Color fundus image · 2352 x 1568 pixels.
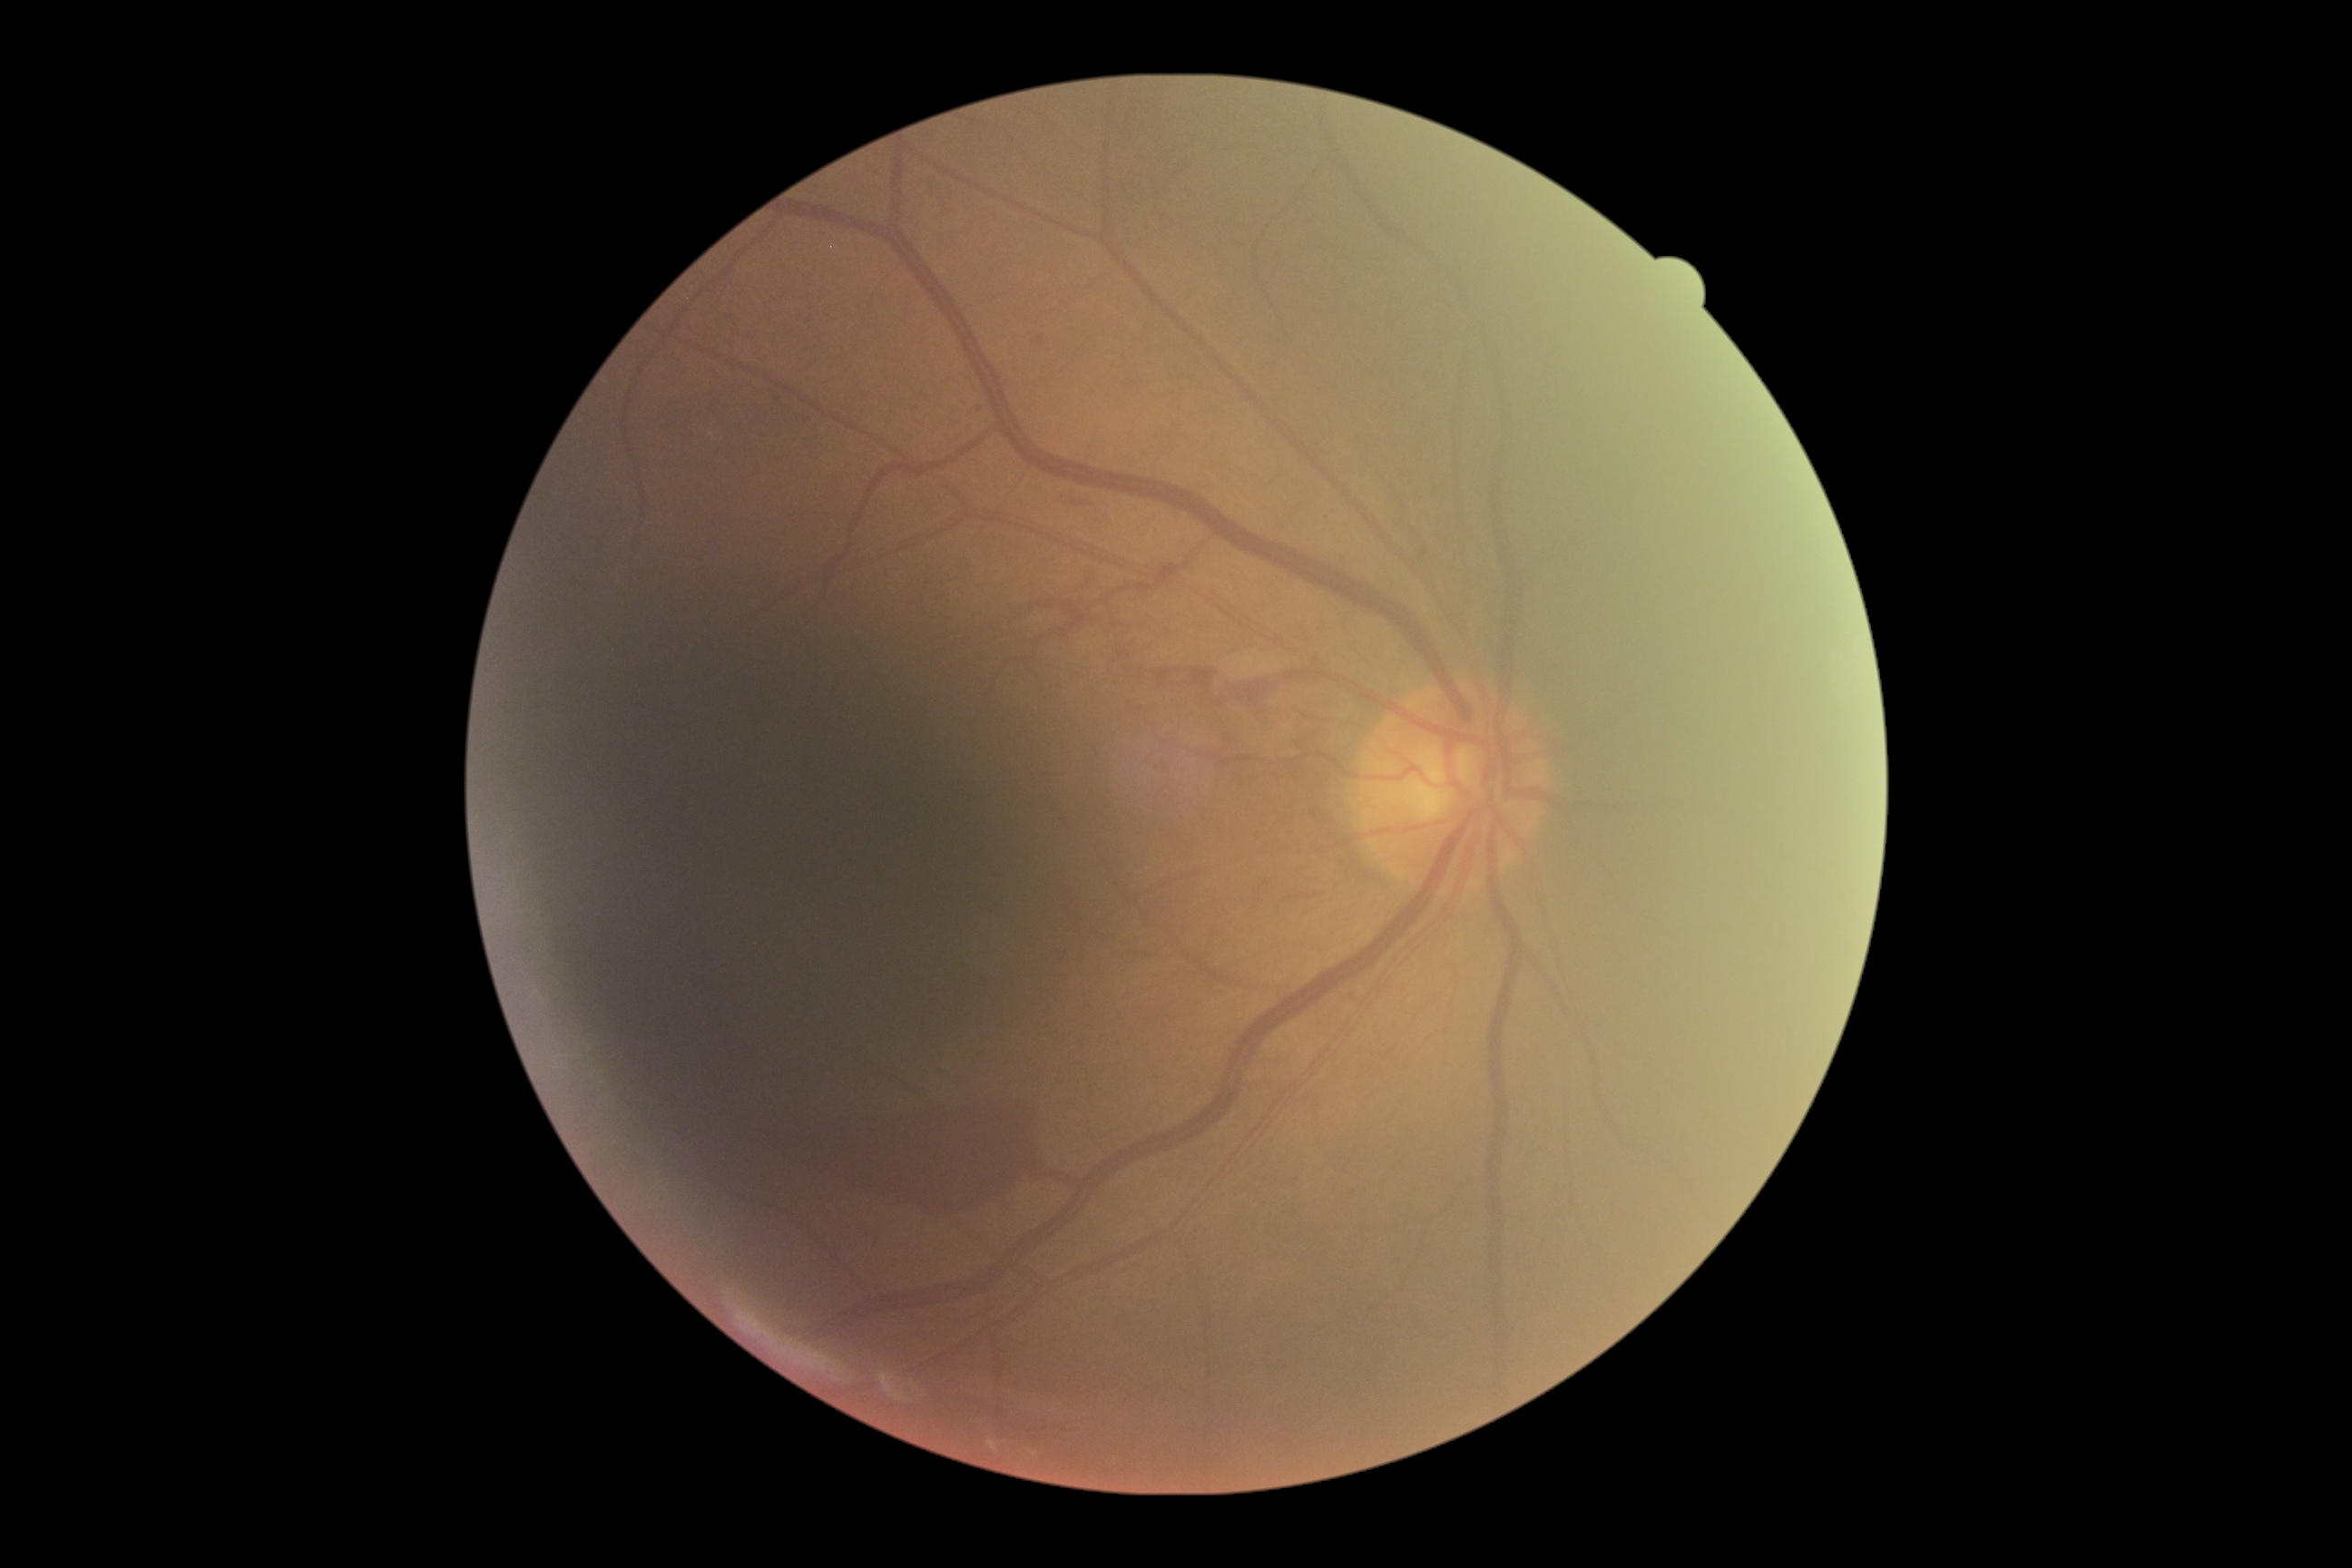

Annotations:
- DR — grade 4 (PDR)